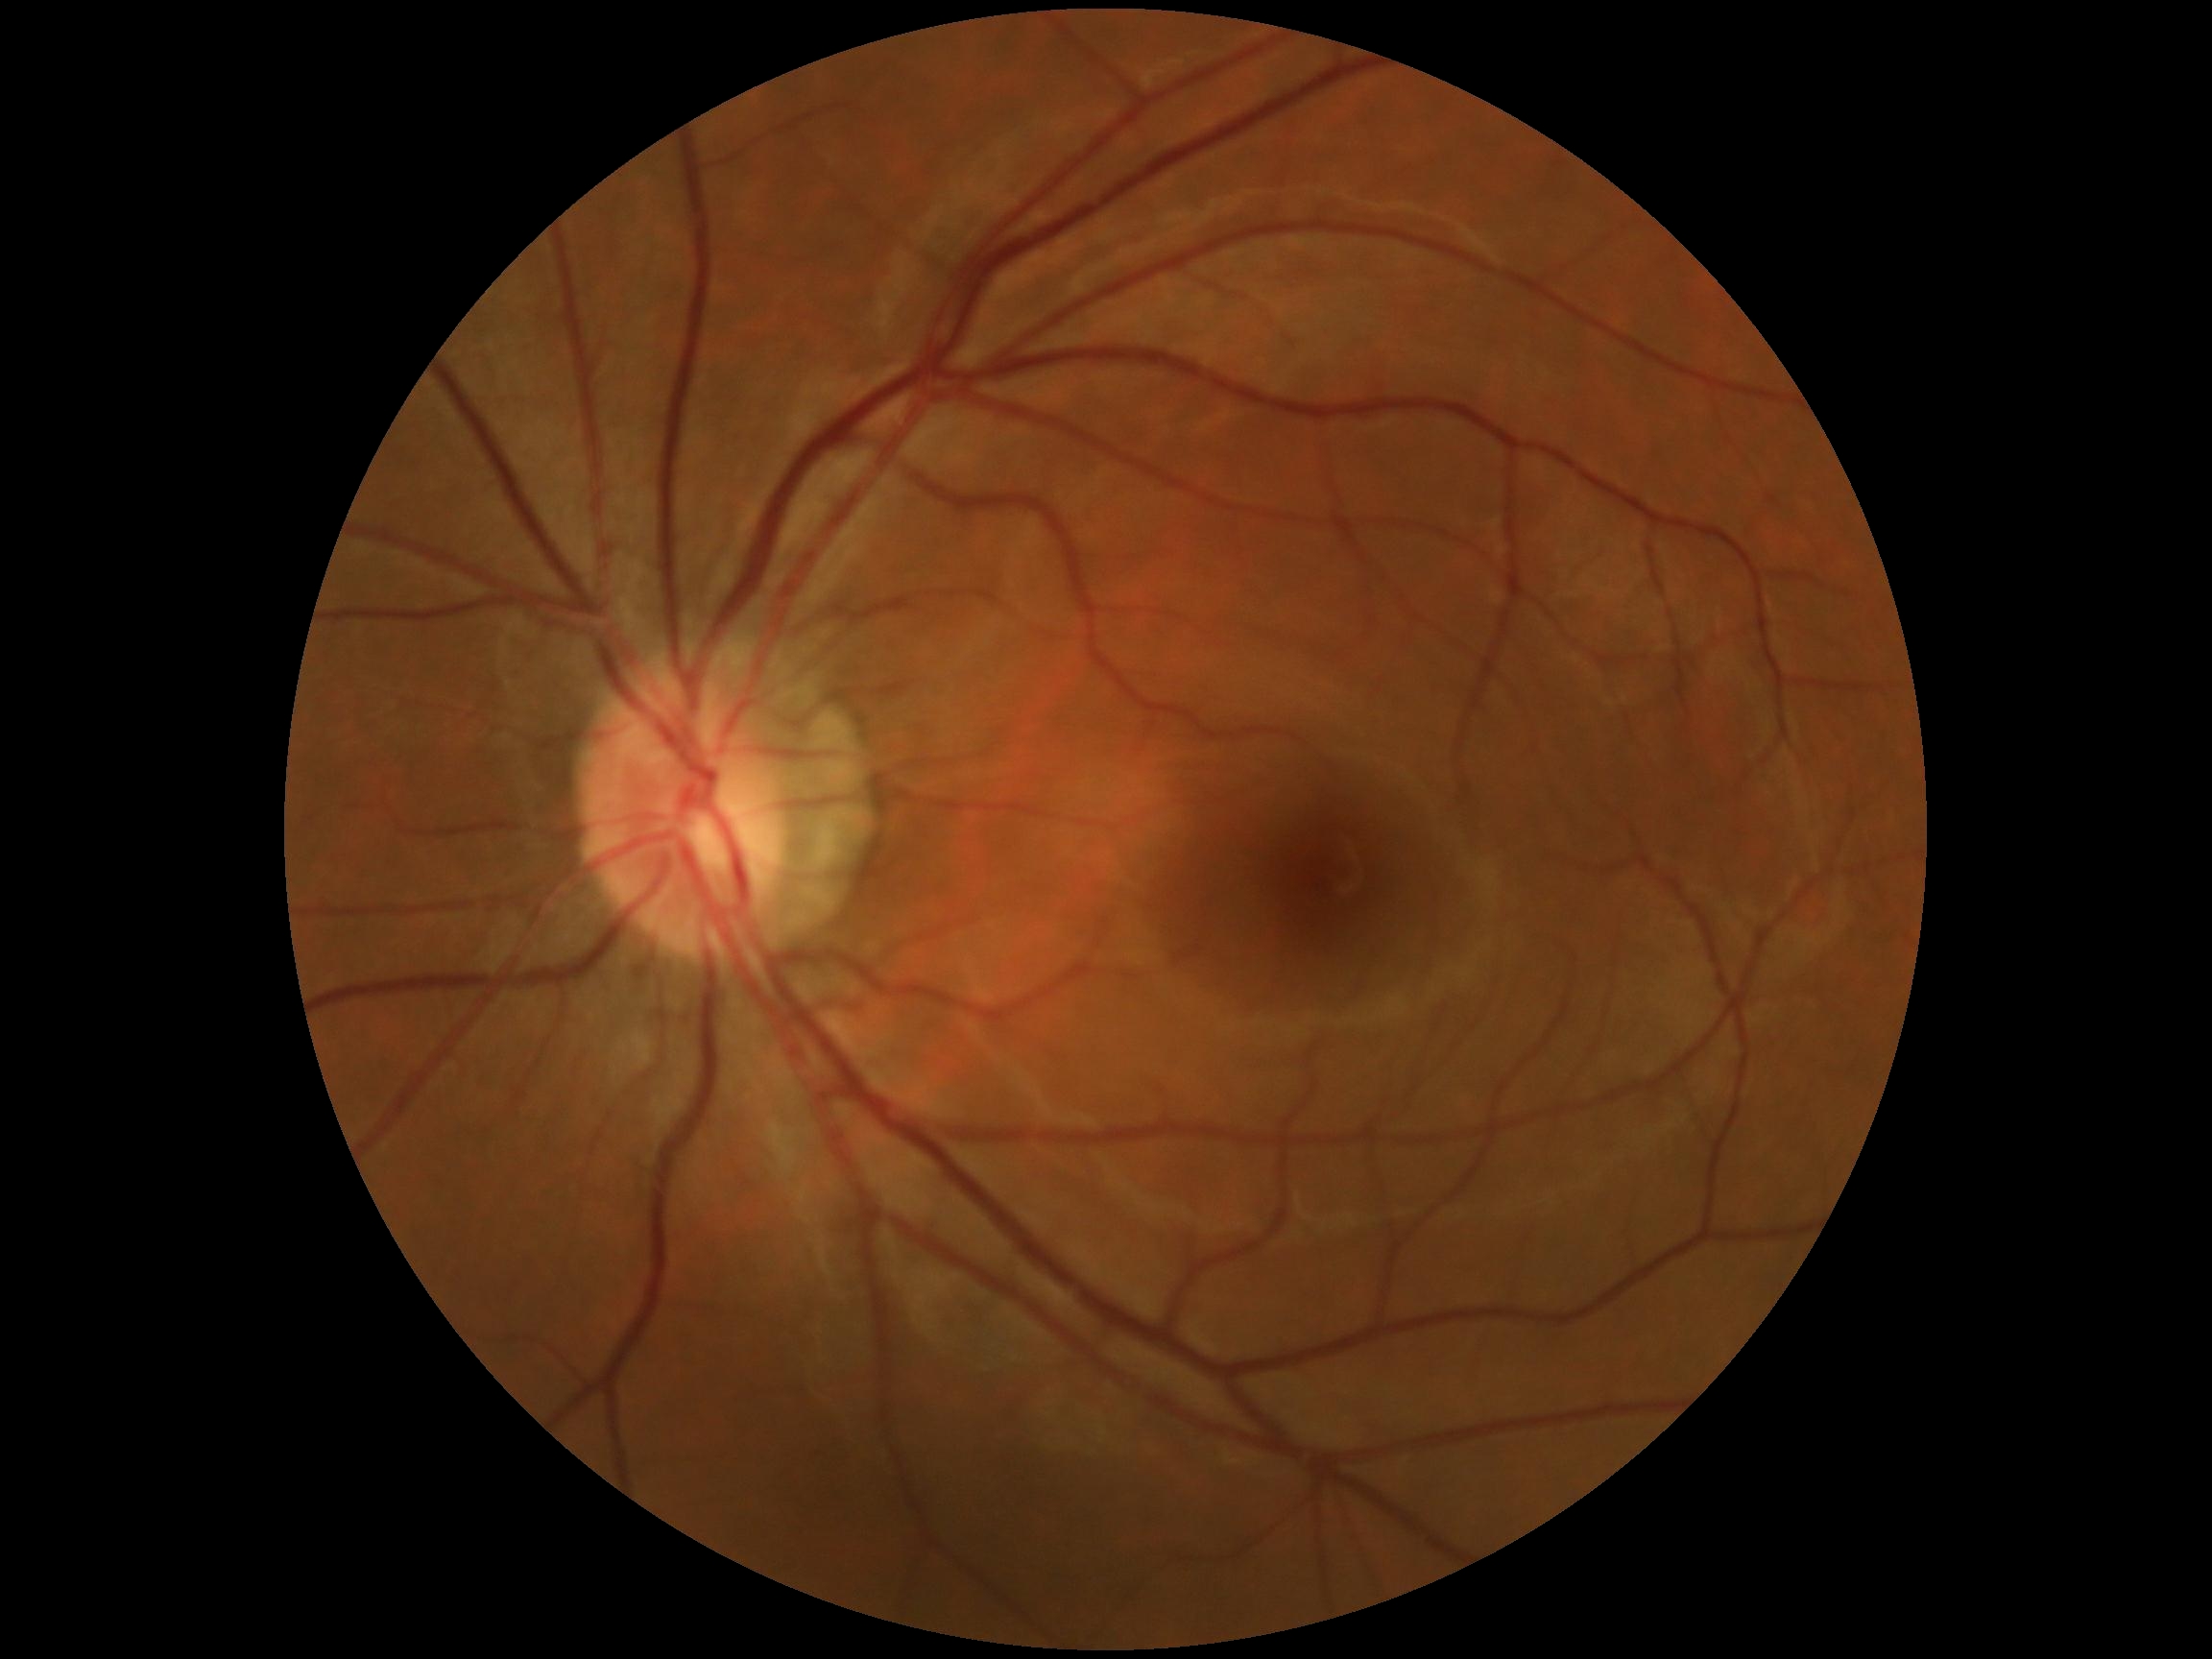
dr_grade: no apparent retinopathy (grade 0)